45-degree field of view: 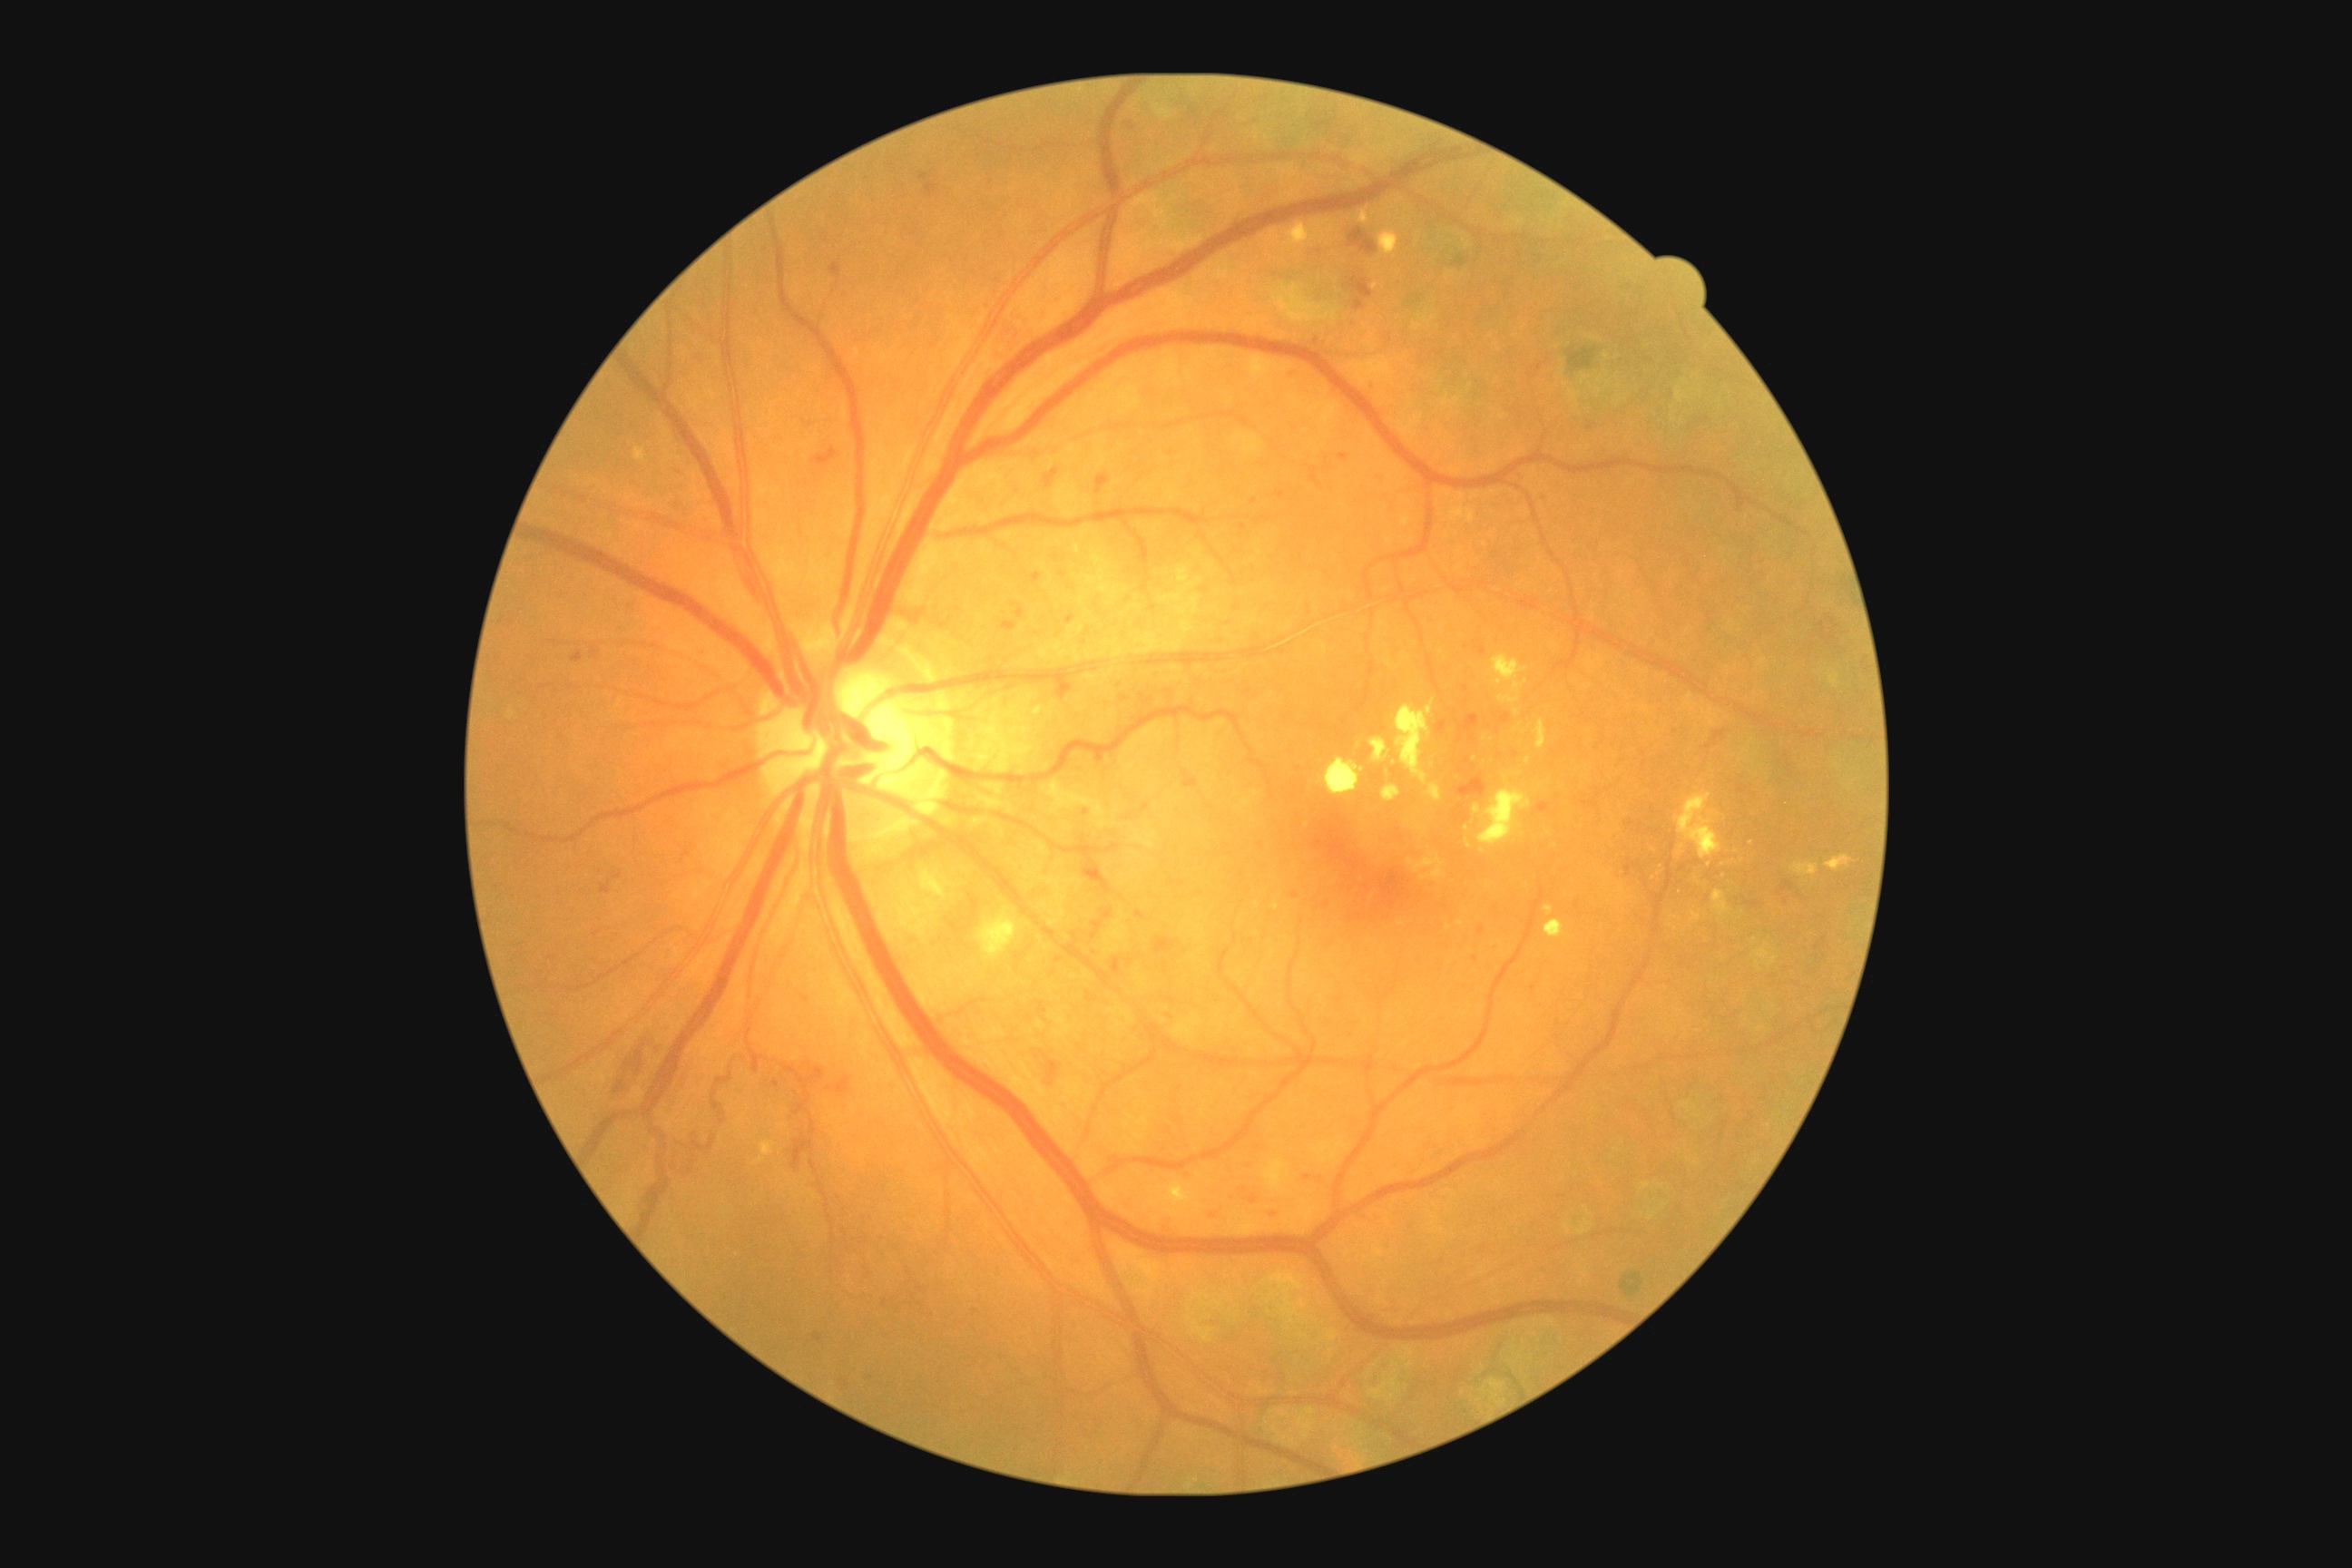 partial: true
dr_grade: 3
dr_grade_name: severe NPDR
lesions:
  he:
    - <bbox>1367, 382, 1380, 395</bbox>
    - <bbox>1306, 1170, 1326, 1188</bbox>
    - <bbox>1182, 770, 1199, 789</bbox>
    - <bbox>799, 995, 810, 1003</bbox>
    - <bbox>1828, 618, 1839, 632</bbox>
    - <bbox>921, 173, 930, 181</bbox>
    - <bbox>1355, 299, 1366, 311</bbox>
    - <bbox>1112, 959, 1122, 975</bbox>
    - <bbox>1348, 228, 1378, 255</bbox>
    - <bbox>839, 1378, 848, 1389</bbox>
    - <bbox>1246, 1195, 1264, 1208</bbox>
    - <bbox>1349, 277, 1373, 299</bbox>
    - <bbox>1014, 603, 1026, 618</bbox>
  he_small_centers:
    - {"x": 1255, "y": 501}
    - {"x": 1294, "y": 896}
    - {"x": 776, "y": 1085}
    - {"x": 1460, "y": 741}